50° field of view, 2228x1652 — 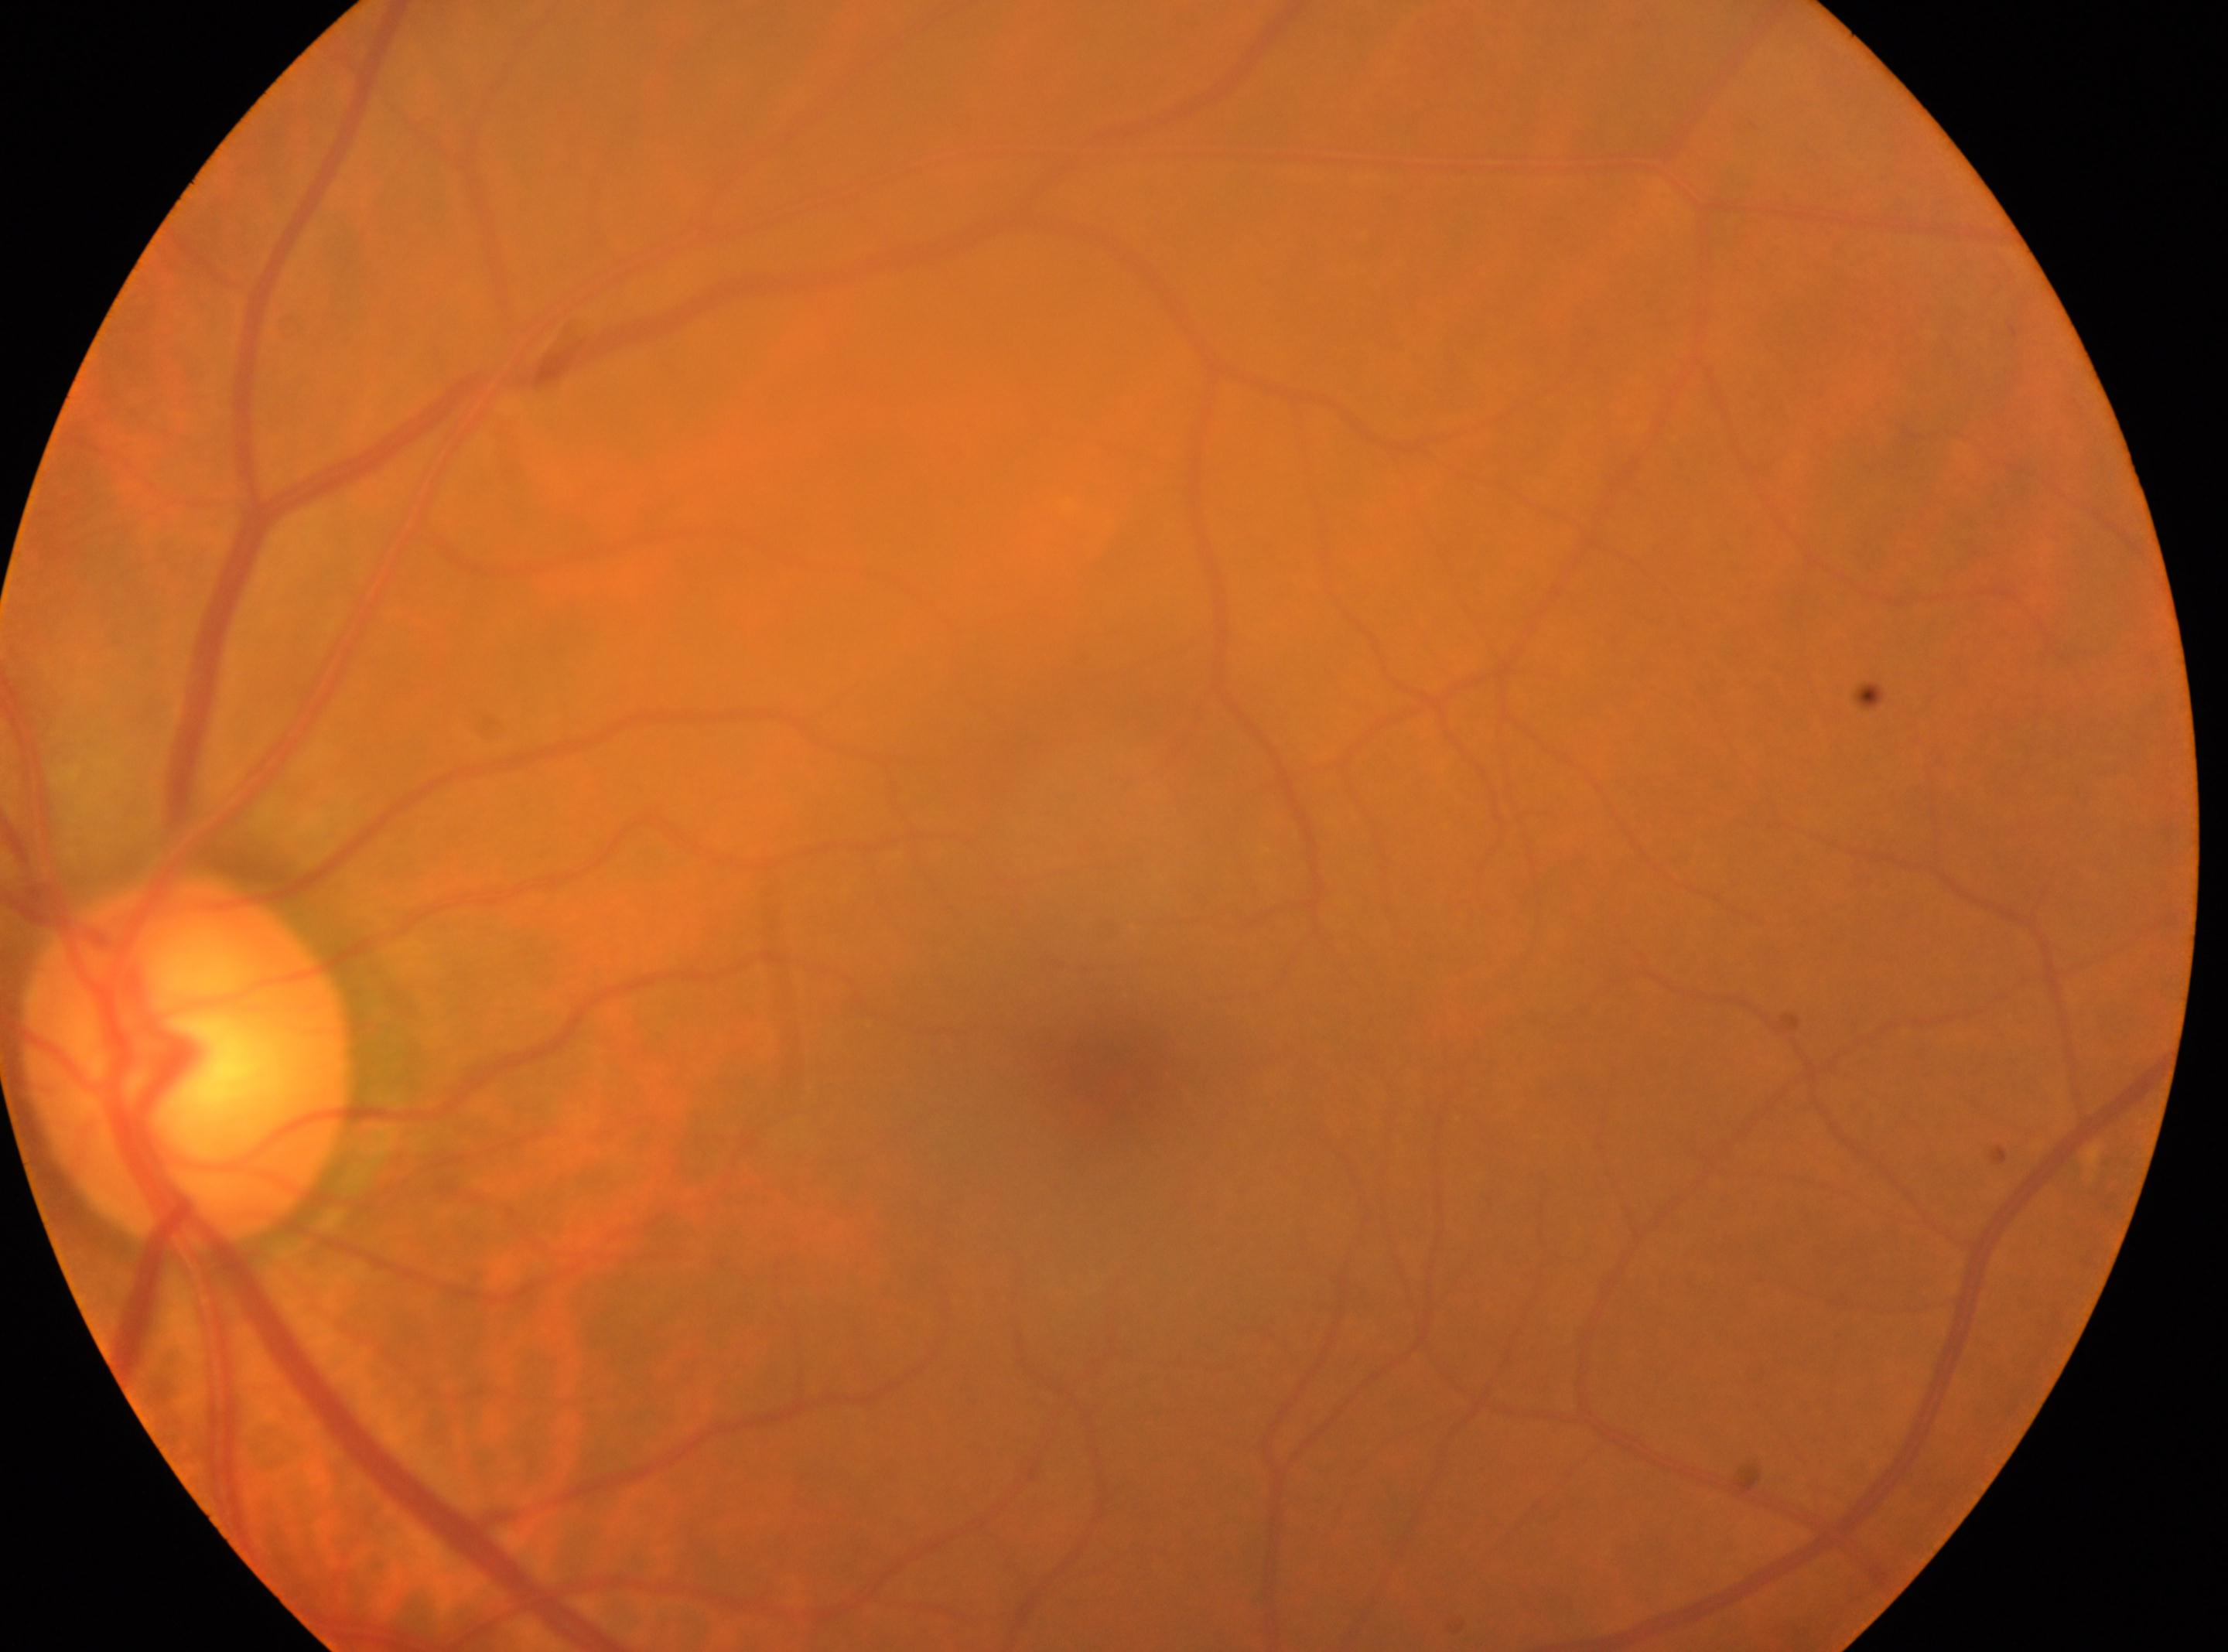 Eye: the left eye.
Optic disc: (187,1064).
Macula center located at (1100,1083).
Diabetic retinopathy is no apparent diabetic retinopathy (grade 0).
No signs of diabetic retinopathy.